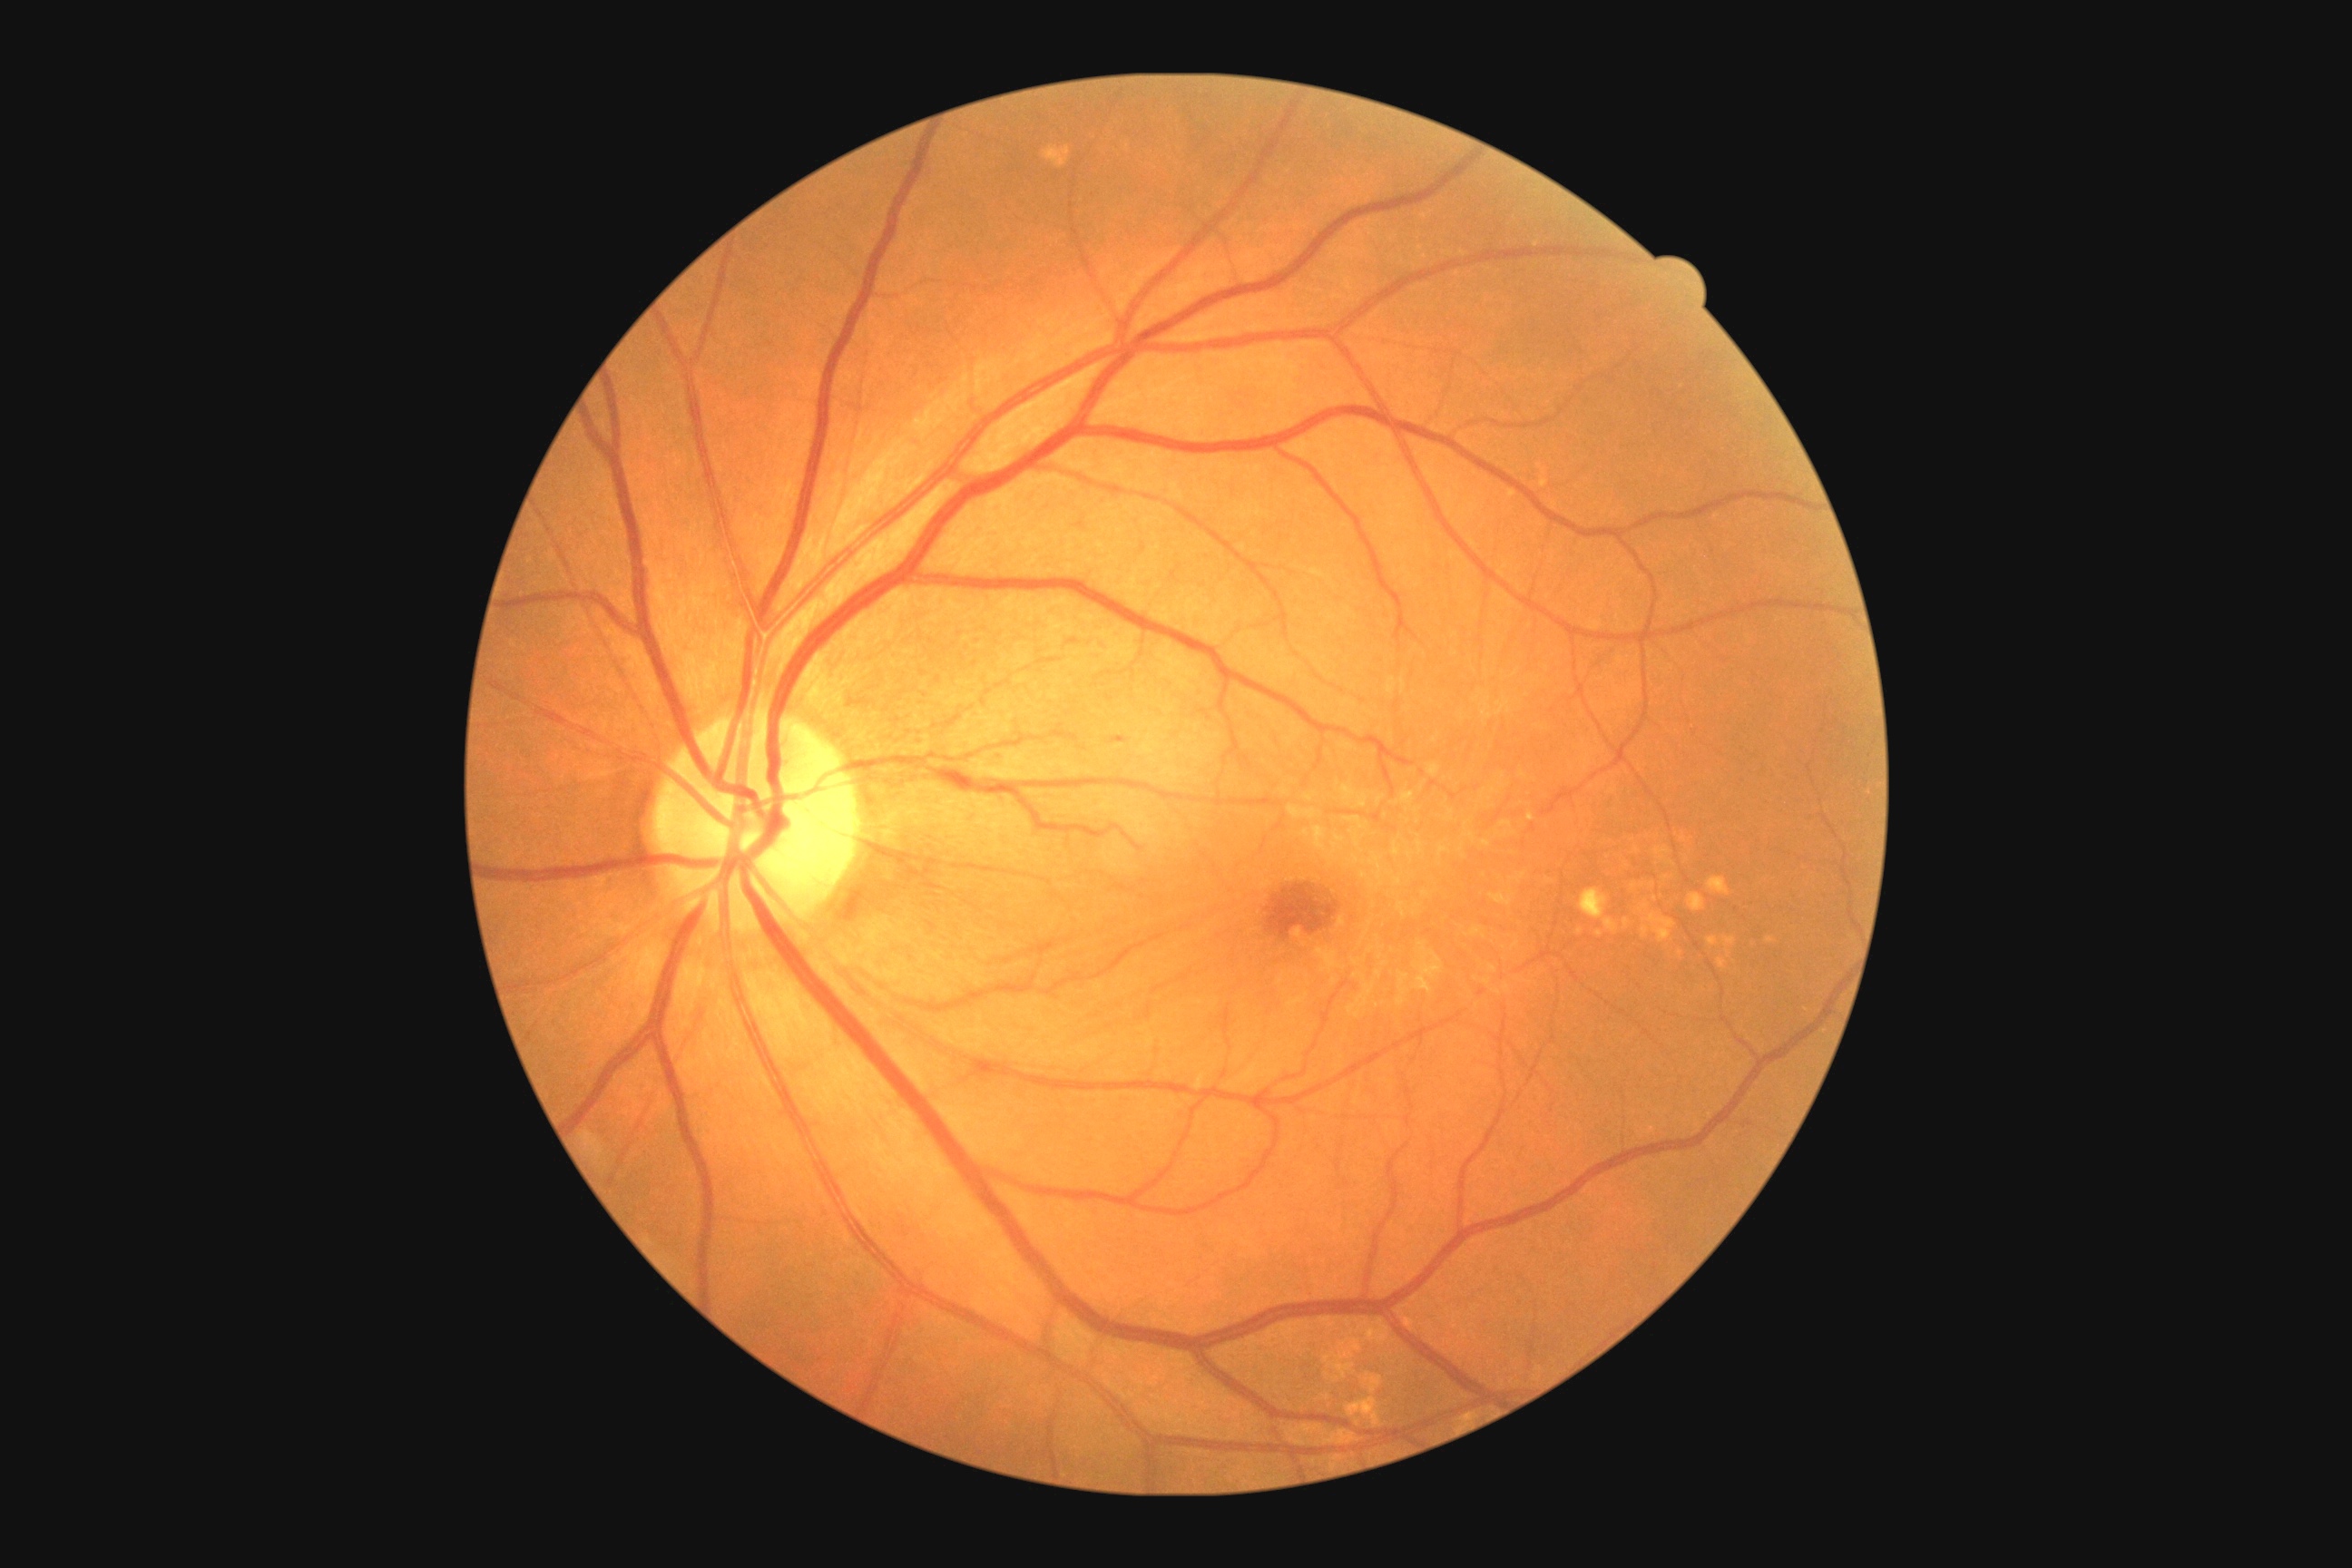

Disease class: non-proliferative diabetic retinopathy.
DR grade is mild NPDR (1) — presence of microaneurysms only.